Phoenix ICON, 100° FOV. Pediatric retinal photograph (wide-field).
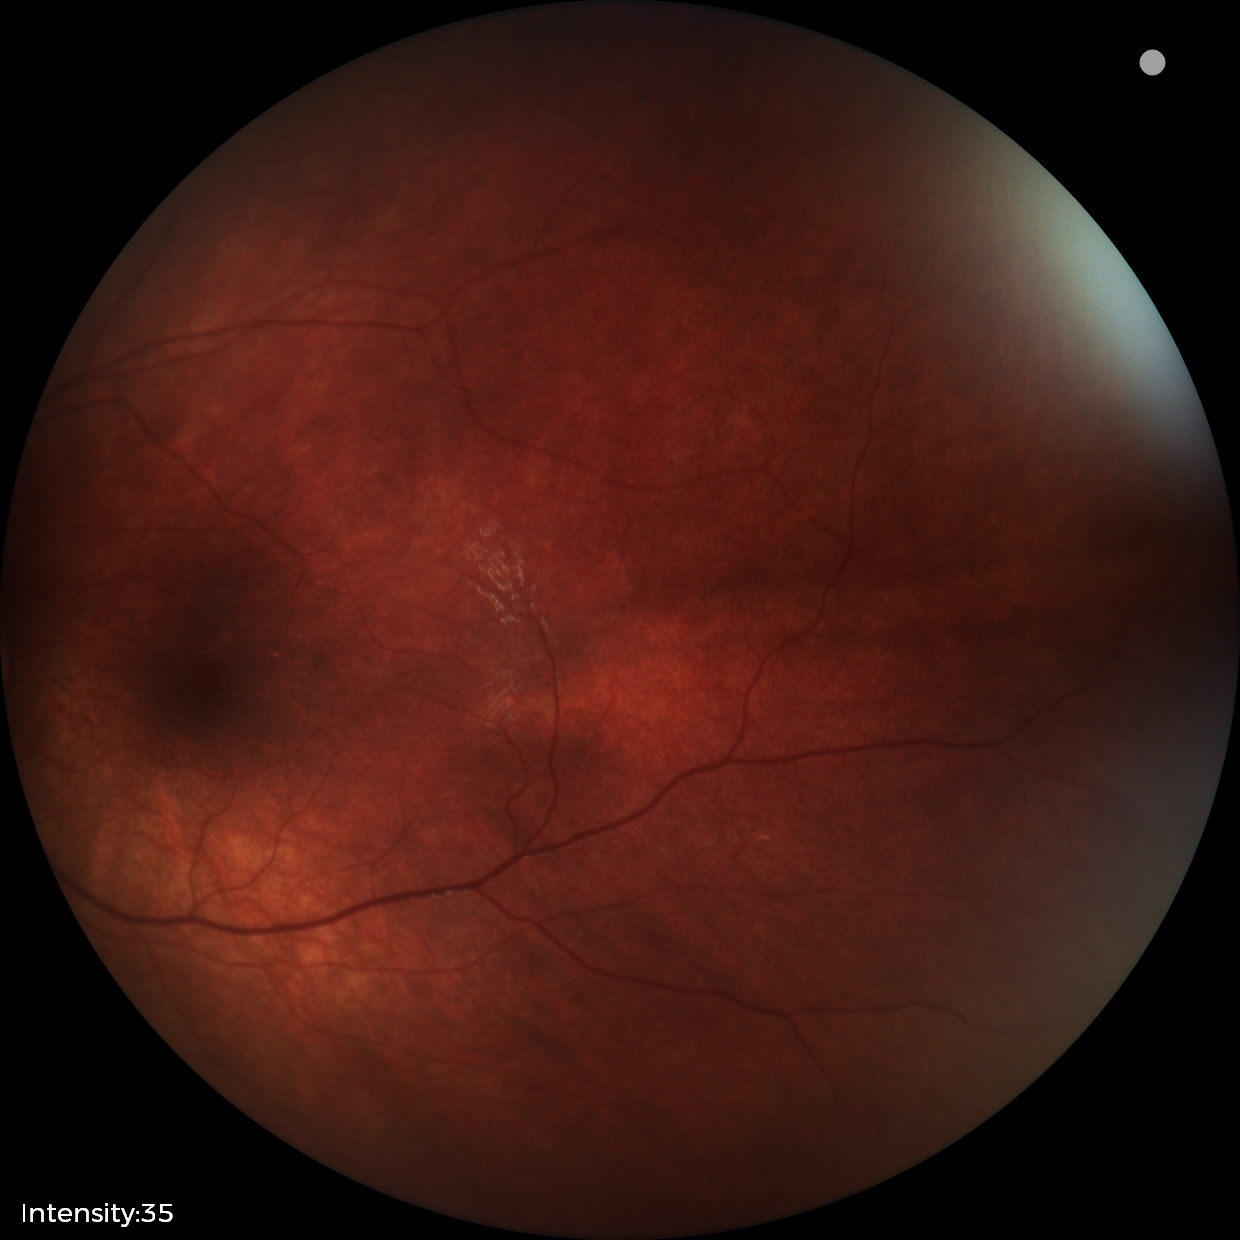

Q: What is the screening diagnosis?
A: retinal astrocytic hamartoma